Phoenix ICON wide-field infant fundus image; camera: Phoenix ICON (100° FOV); image size 1240x1240 — 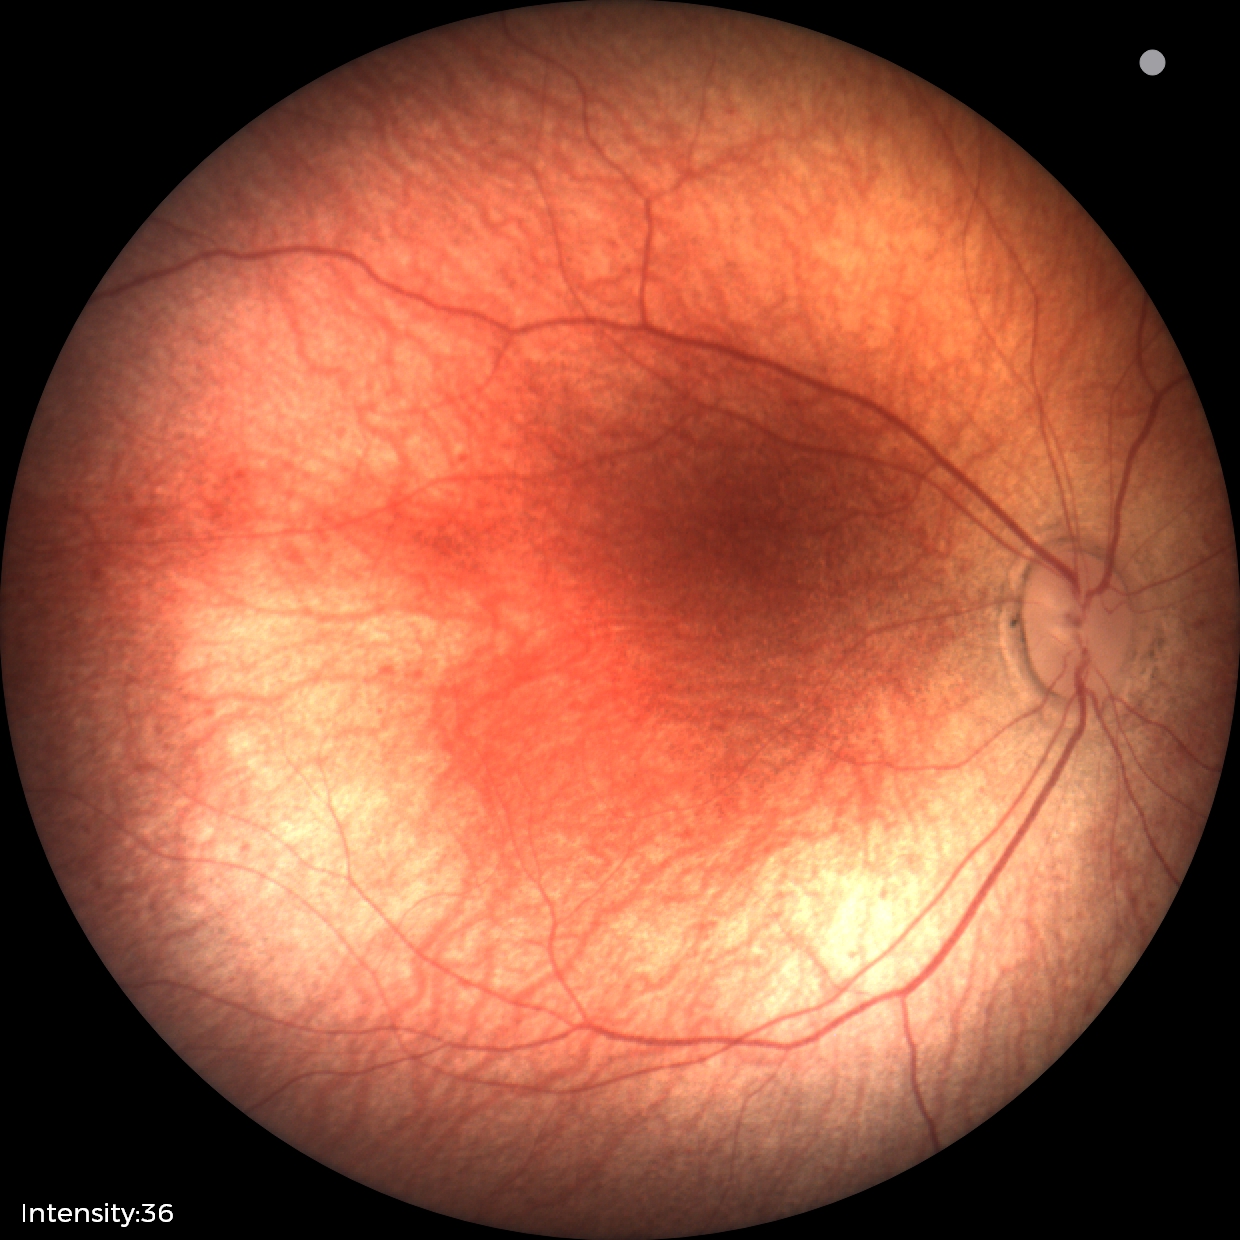 Q: What is the diagnosis from this examination?
A: physiological finding